Posterior pole photograph. 45-degree field of view:
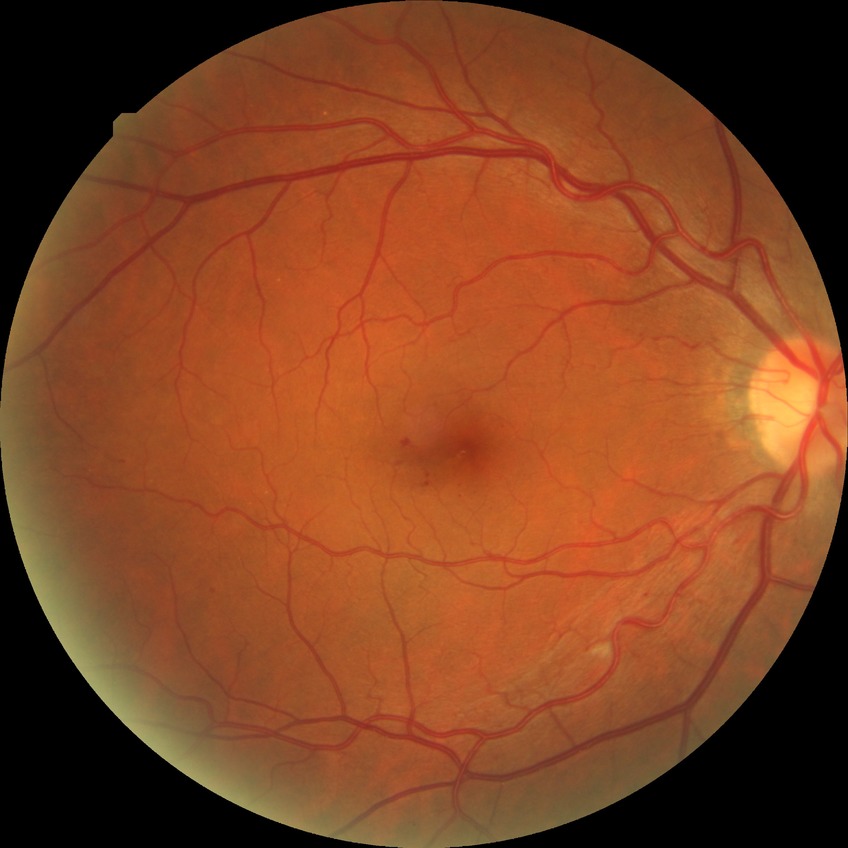

Diabetic retinopathy (DR) is SDR (simple diabetic retinopathy).